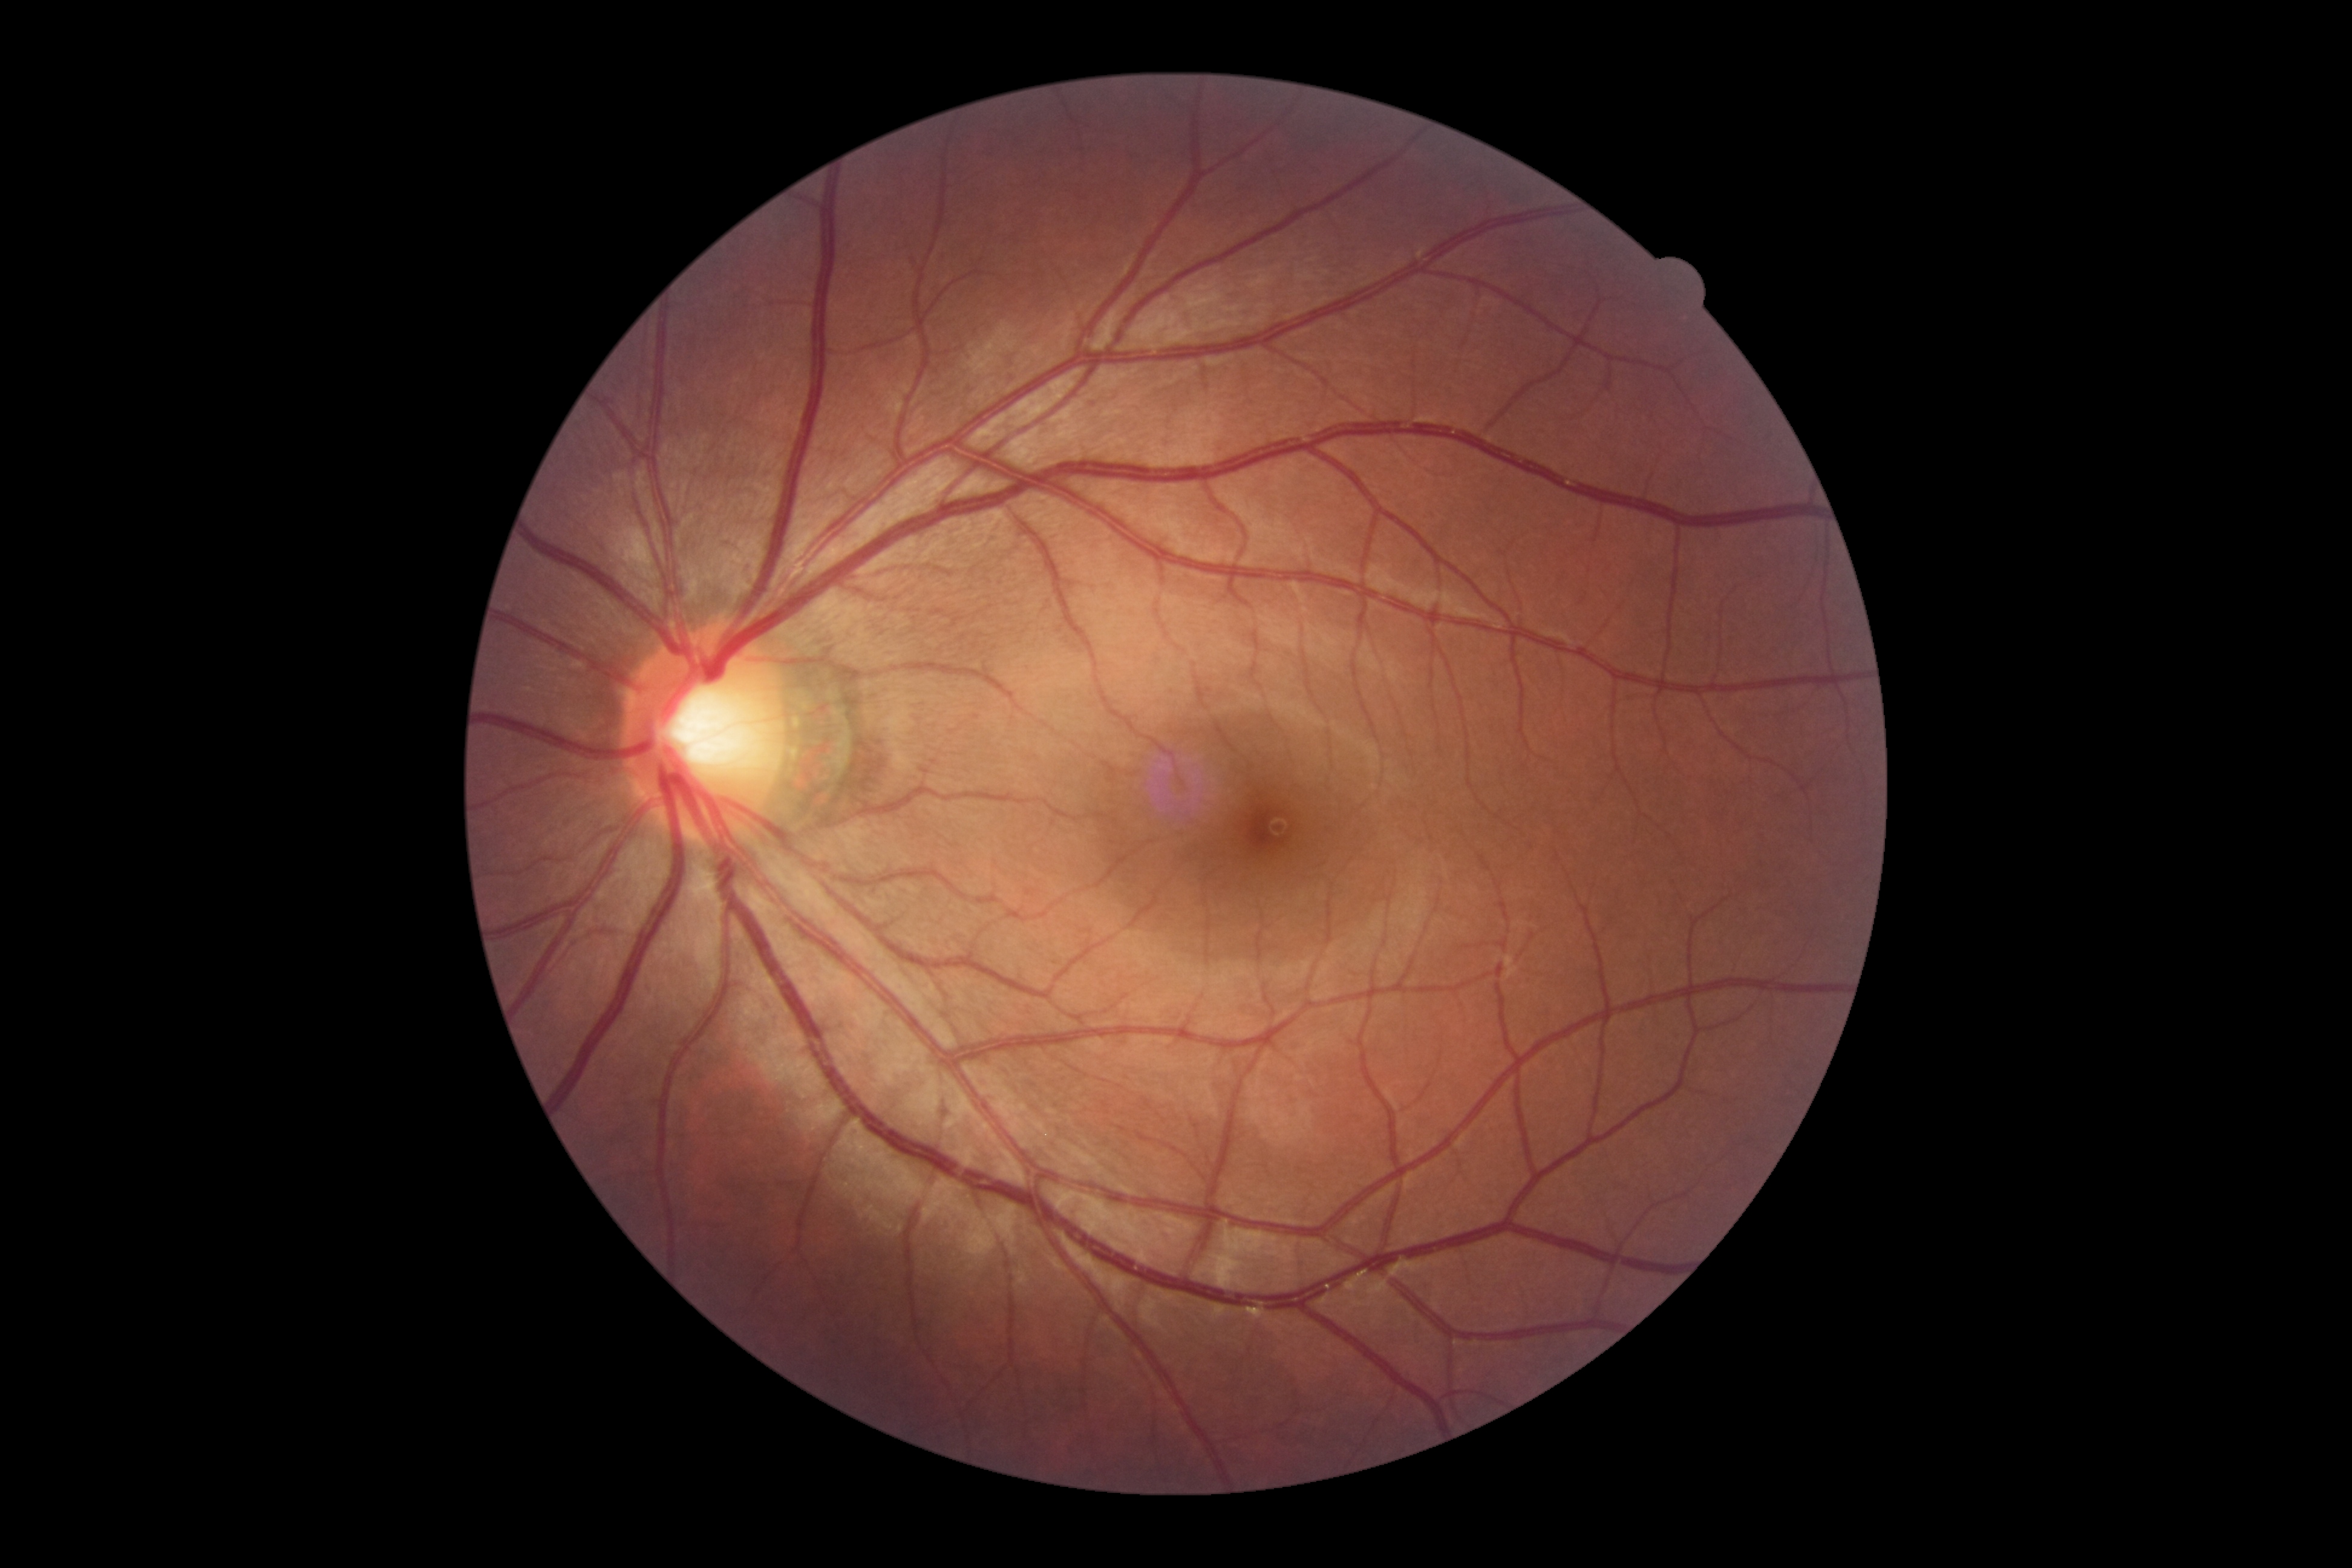
No signs of diabetic retinopathy. Diabetic retinopathy (DR) is no apparent diabetic retinopathy (grade 0).